45° field of view, 2352x1568px, retinal fundus photograph:
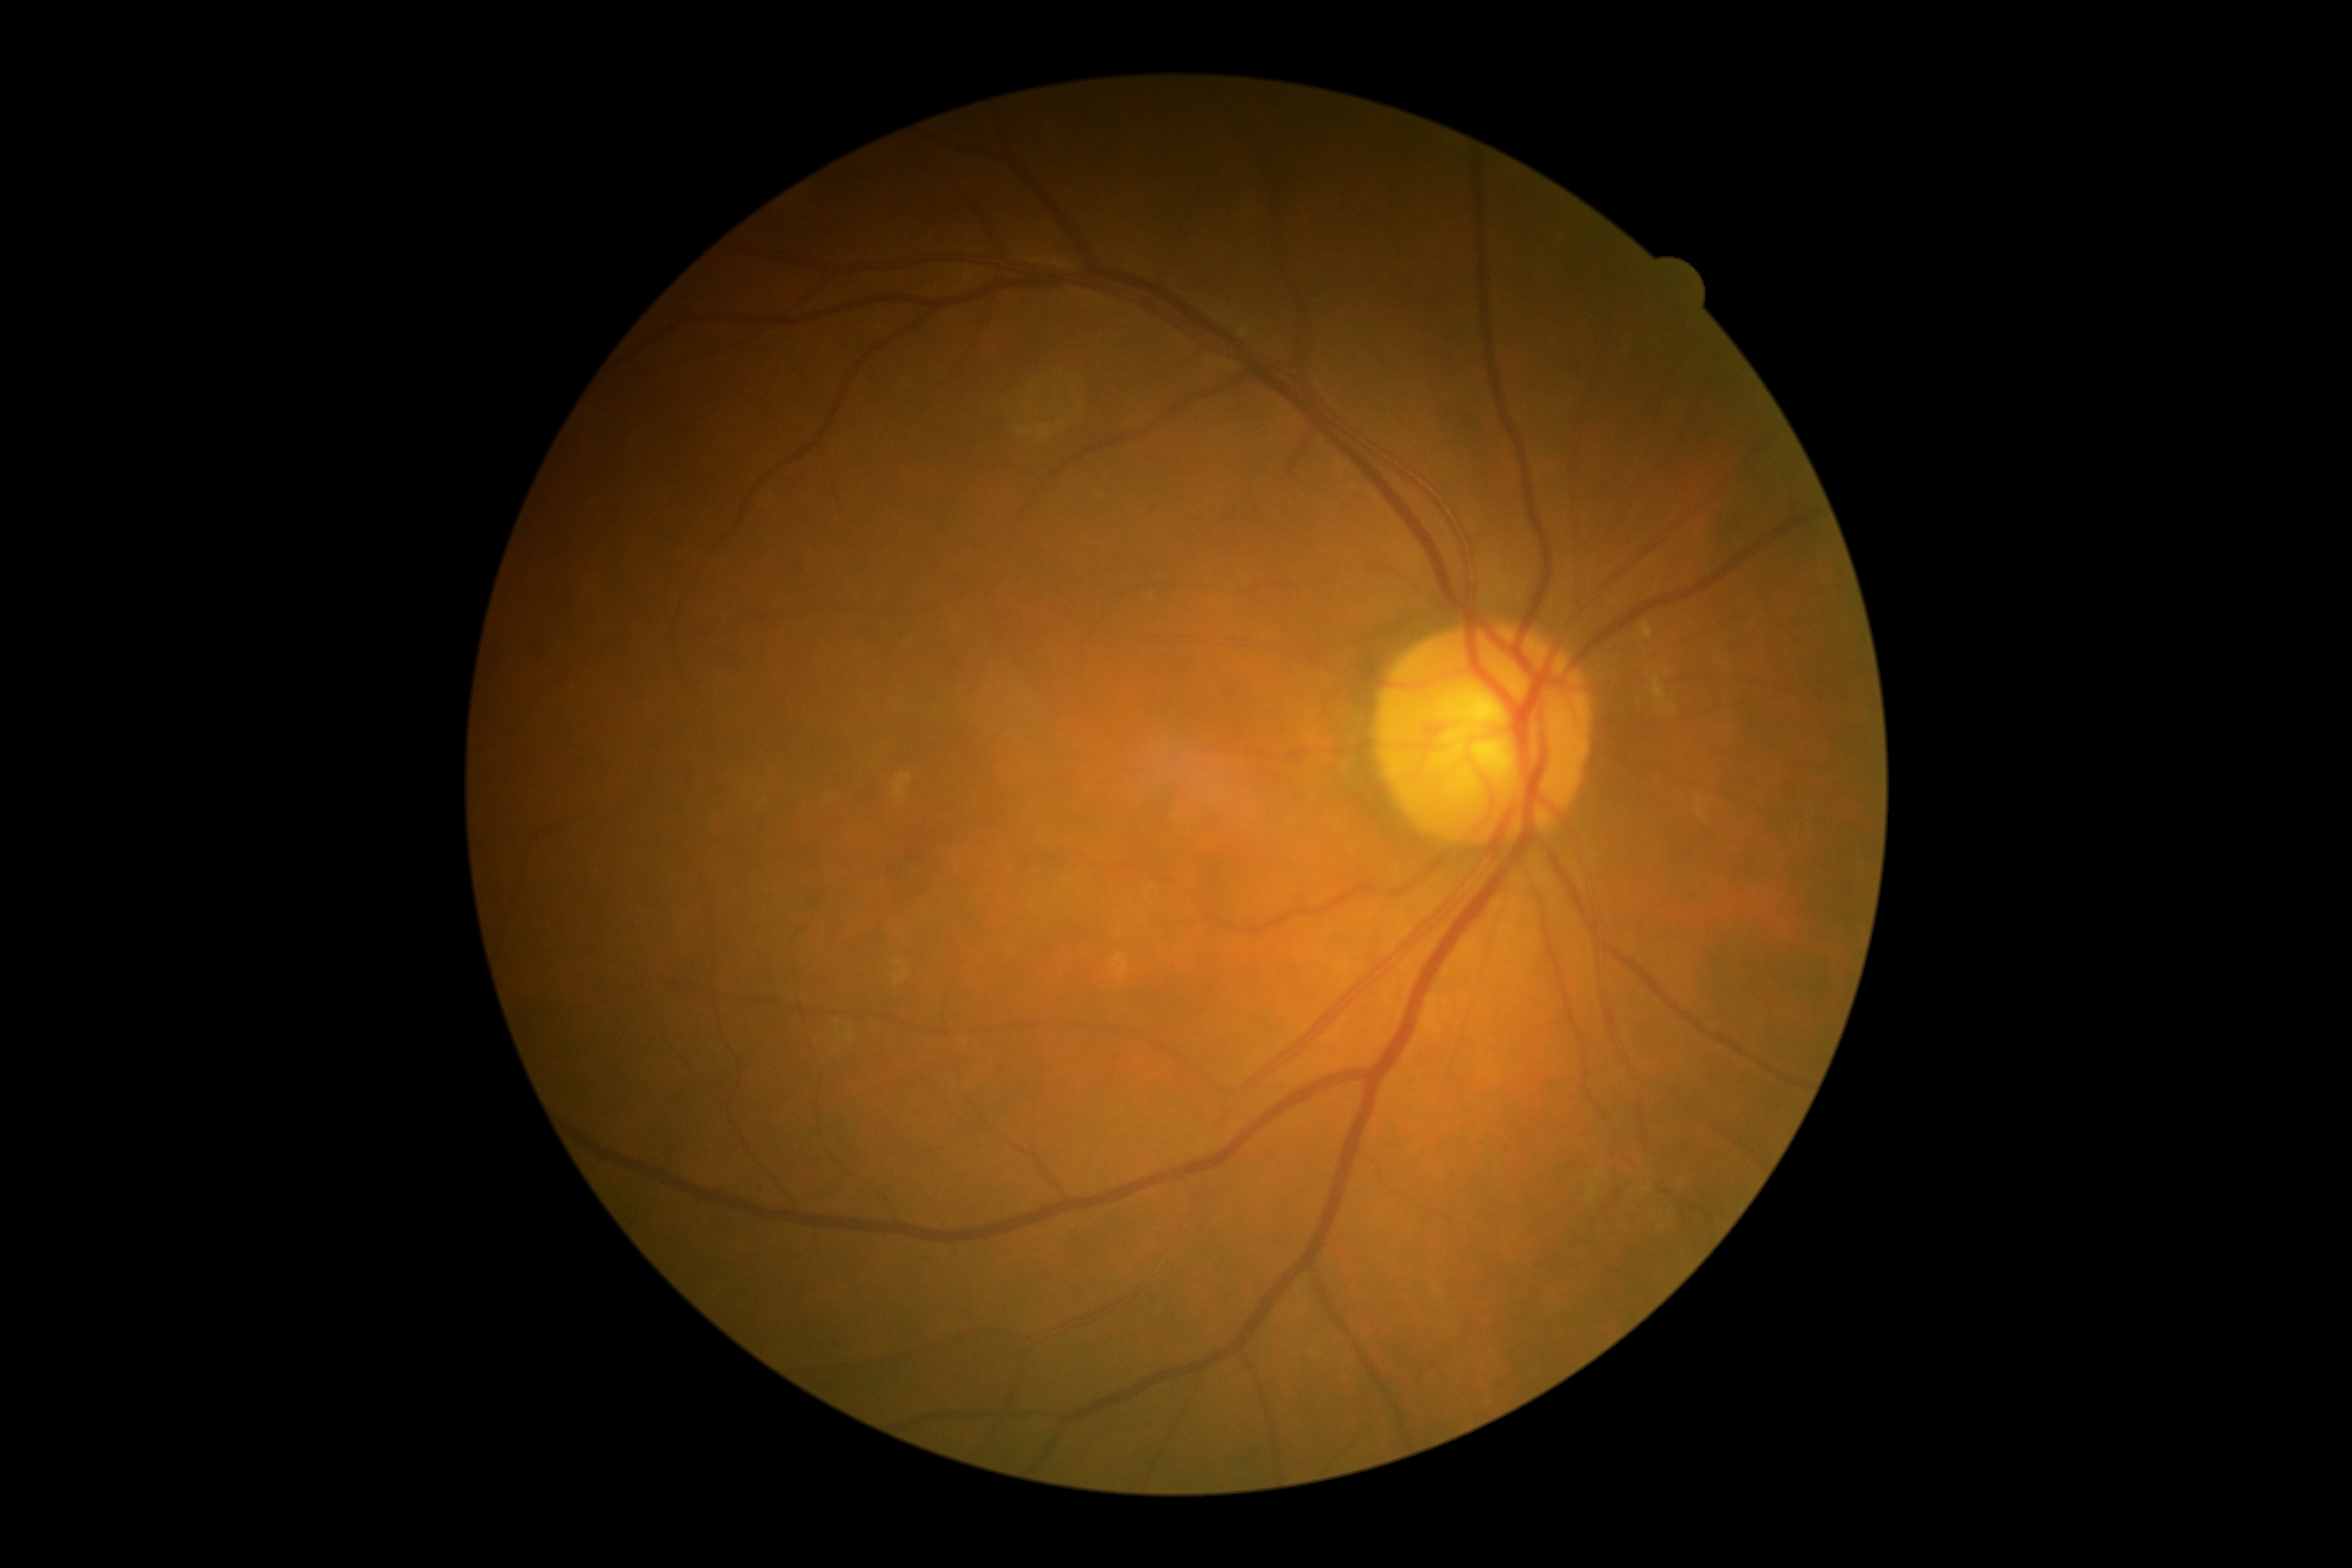 diabetic retinopathy (DR) = grade 2 (moderate NPDR).